45° FOV · fundus photo: 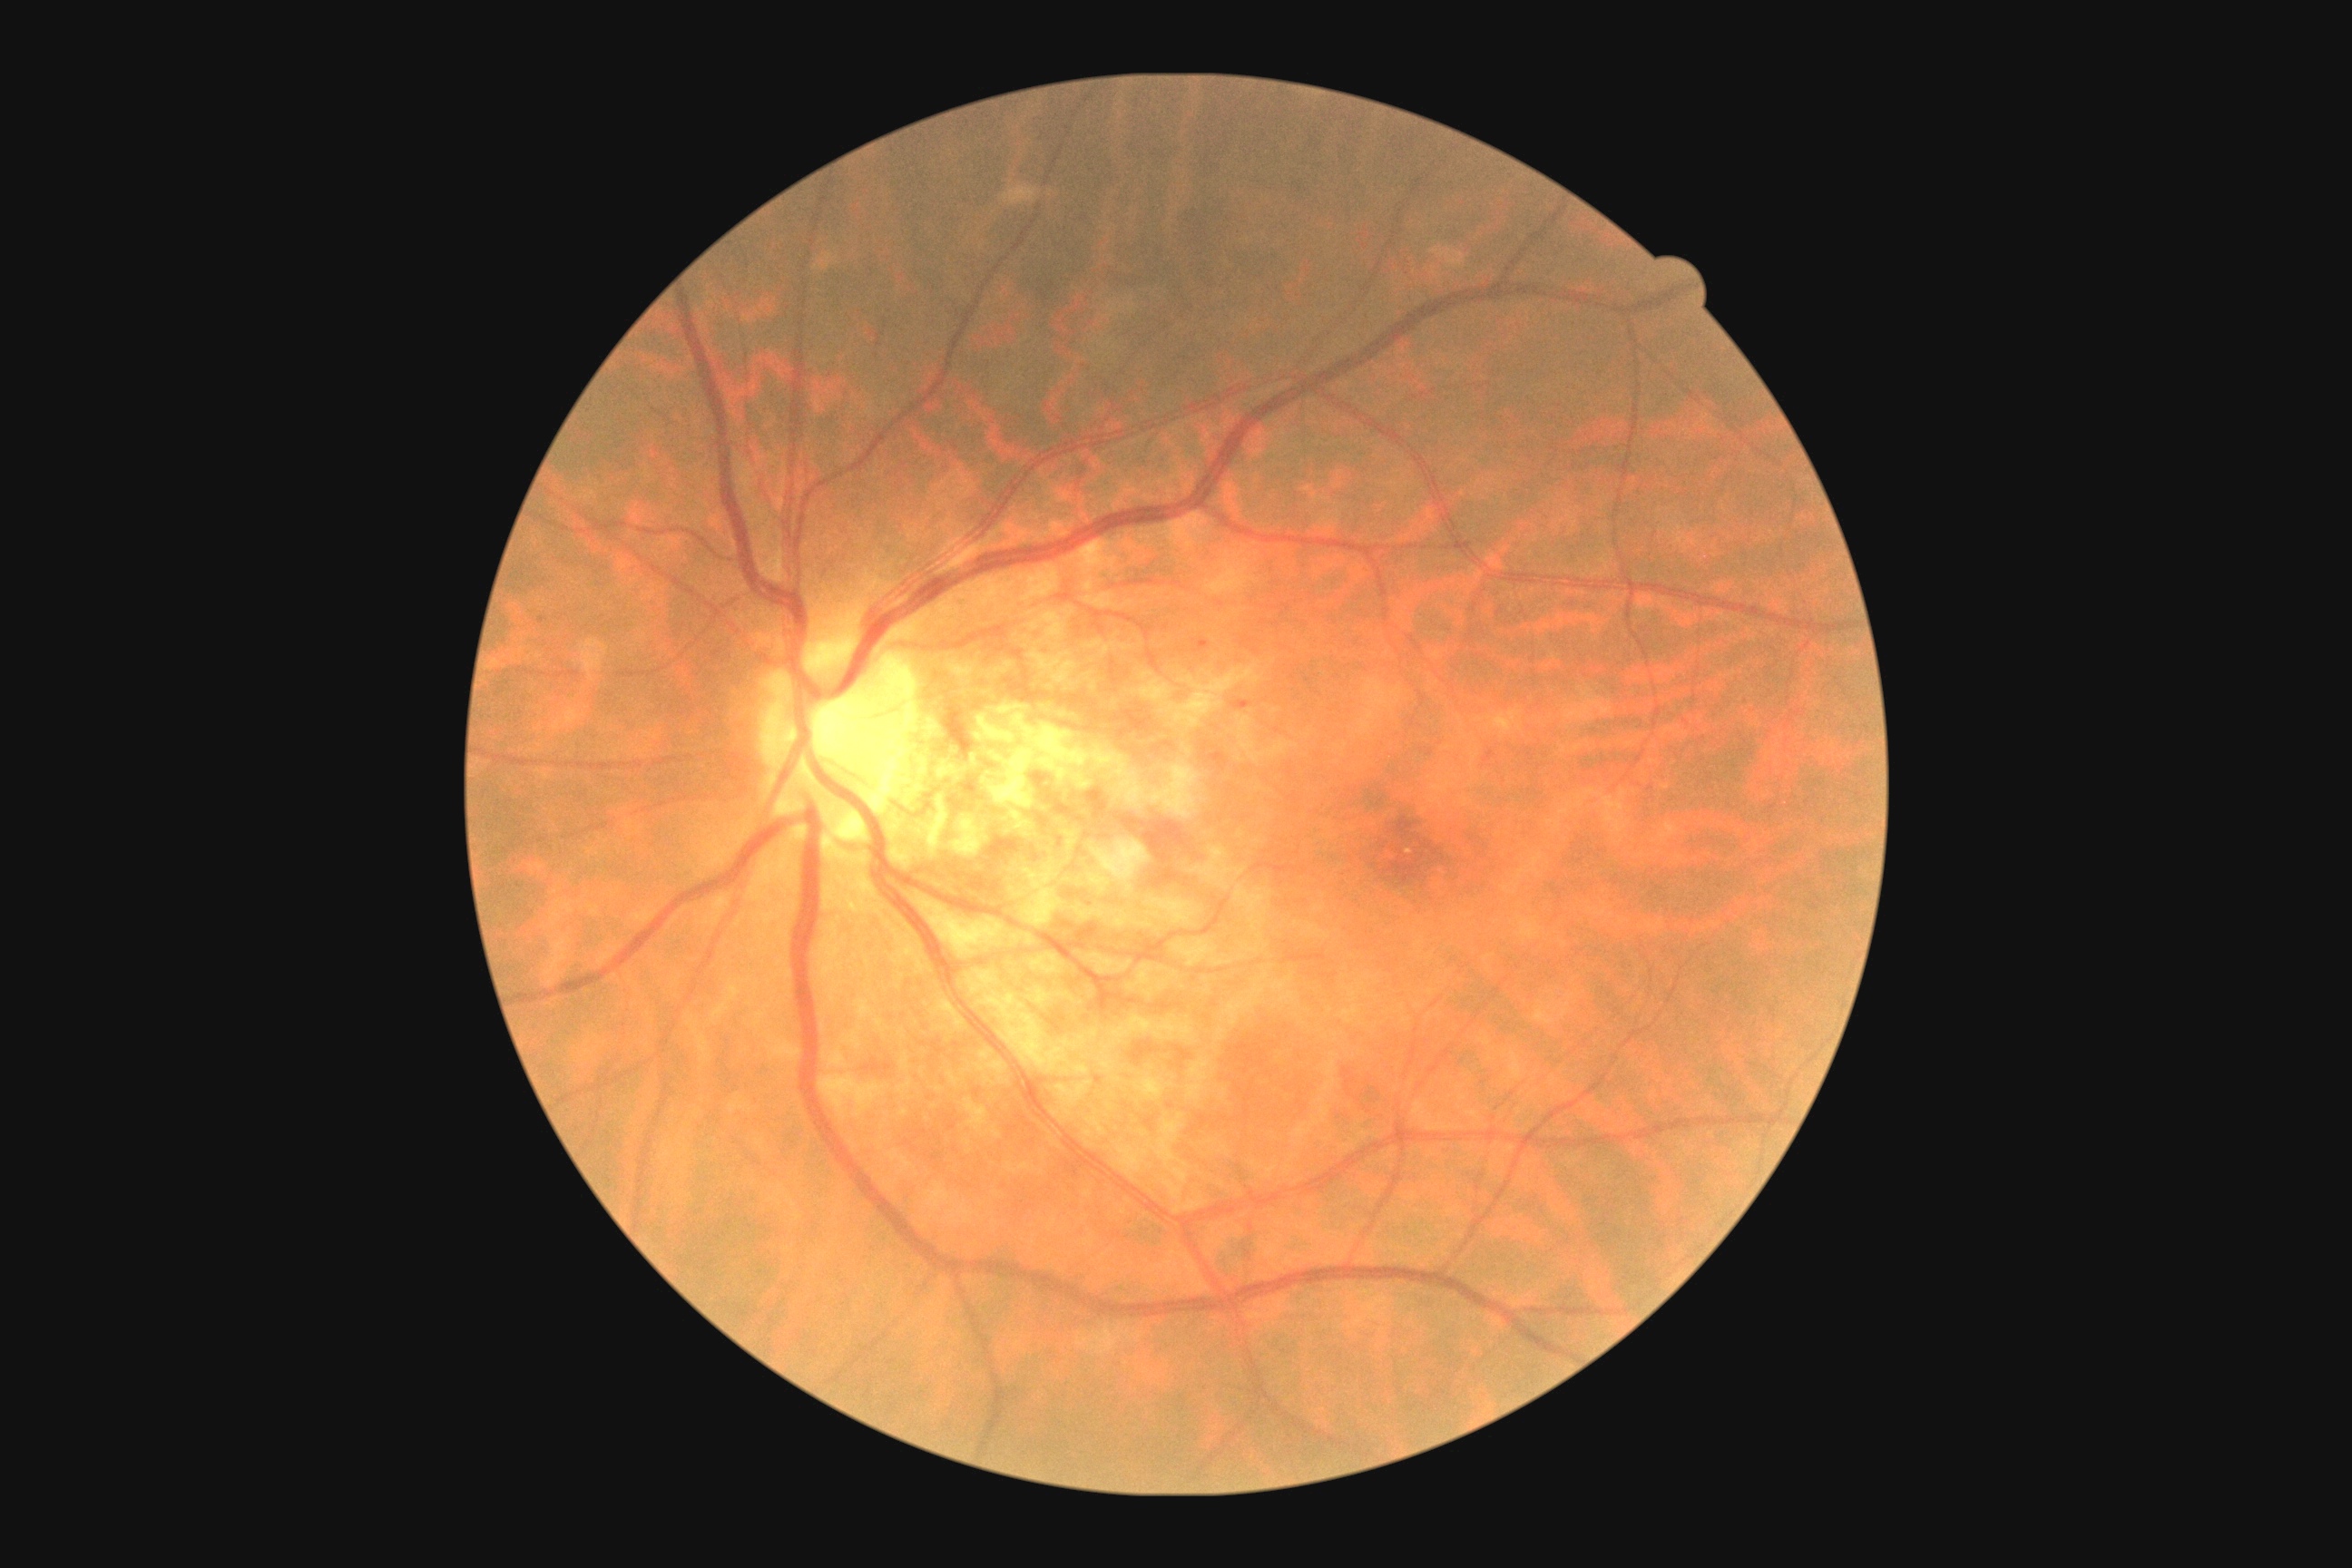 DR class: non-proliferative diabetic retinopathy. Diabetic retinopathy is grade 1 (mild NPDR).